RetCam wide-field infant fundus image: 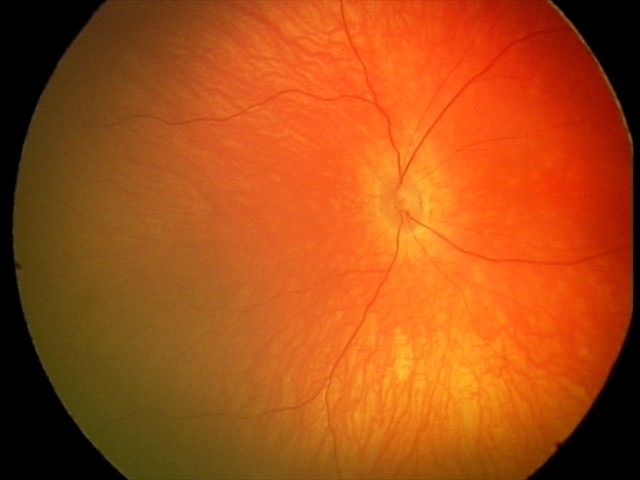 Q: What is the screening diagnosis?
A: physiological retinal finding